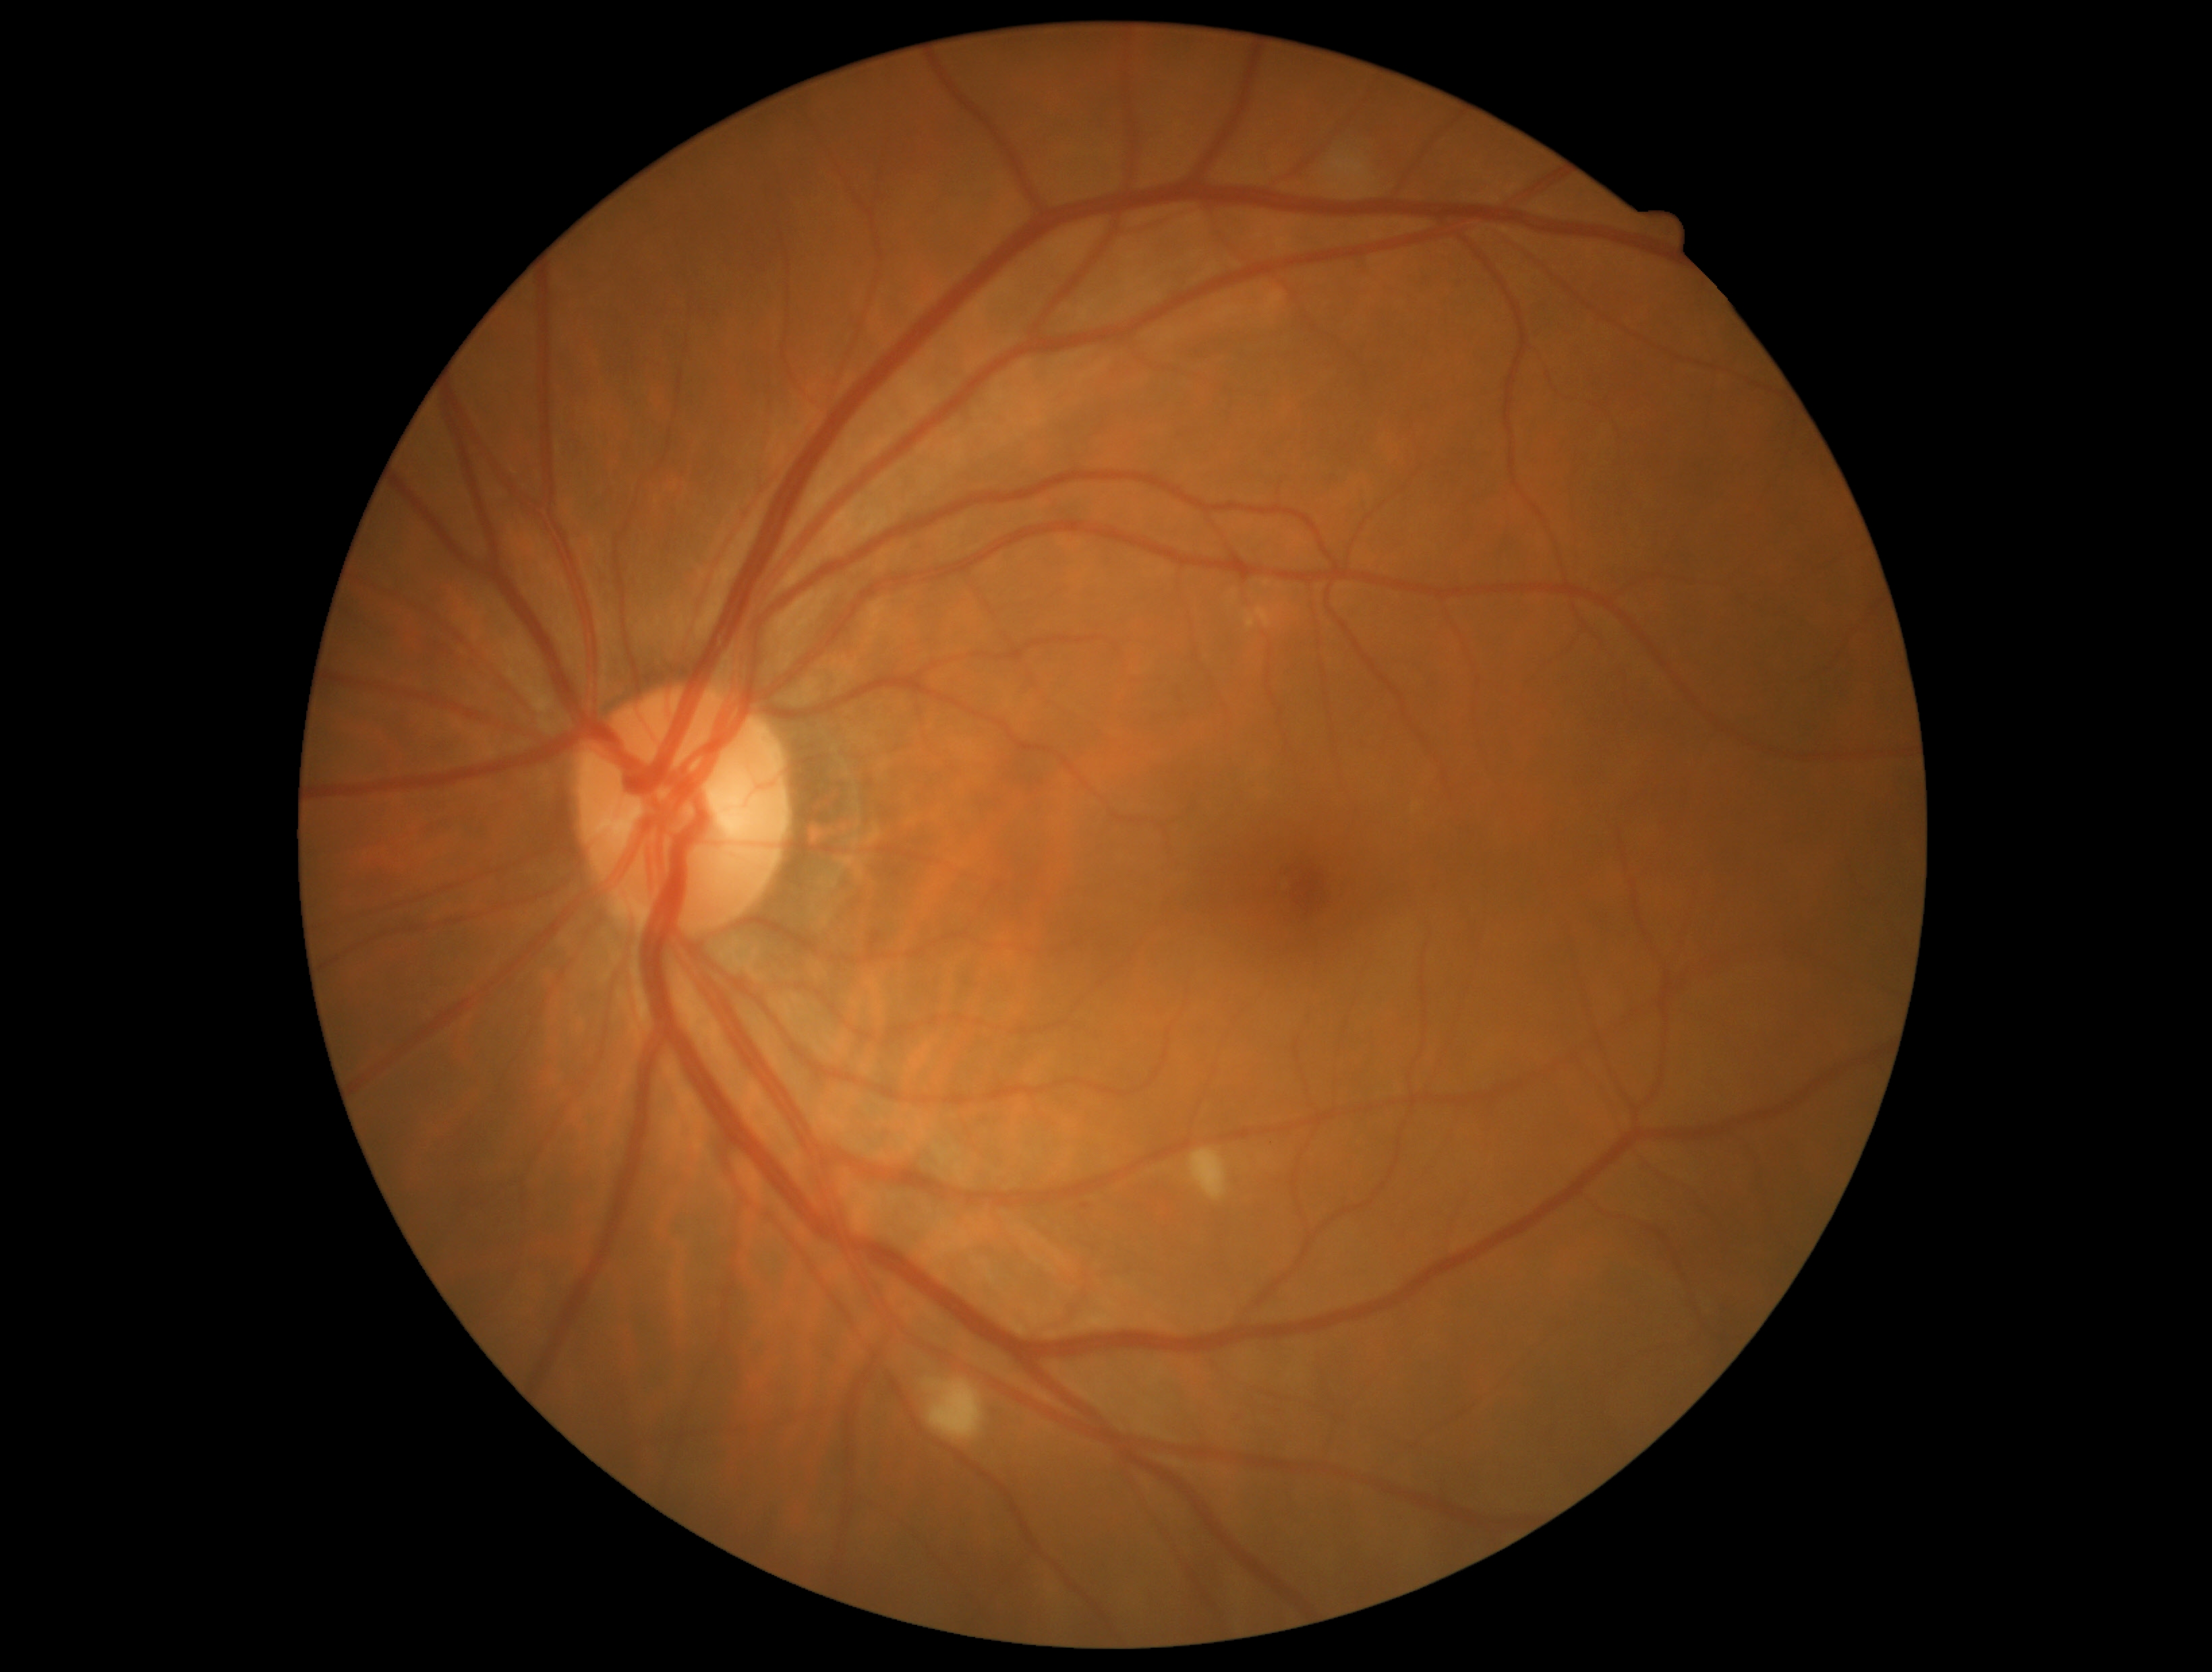 Retinopathy is grade 2 — more than just microaneurysms but less than severe NPDR.